Captured on a Nidek AFC-330 fundus camera, non-mydriatic fundus camera, 240 x 240 pixels: 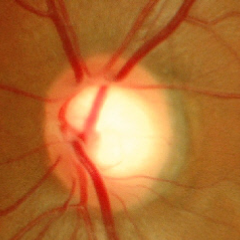

Showing no glaucomatous findings.